CFP. 45-degree field of view. 2352 by 1568 pixels:
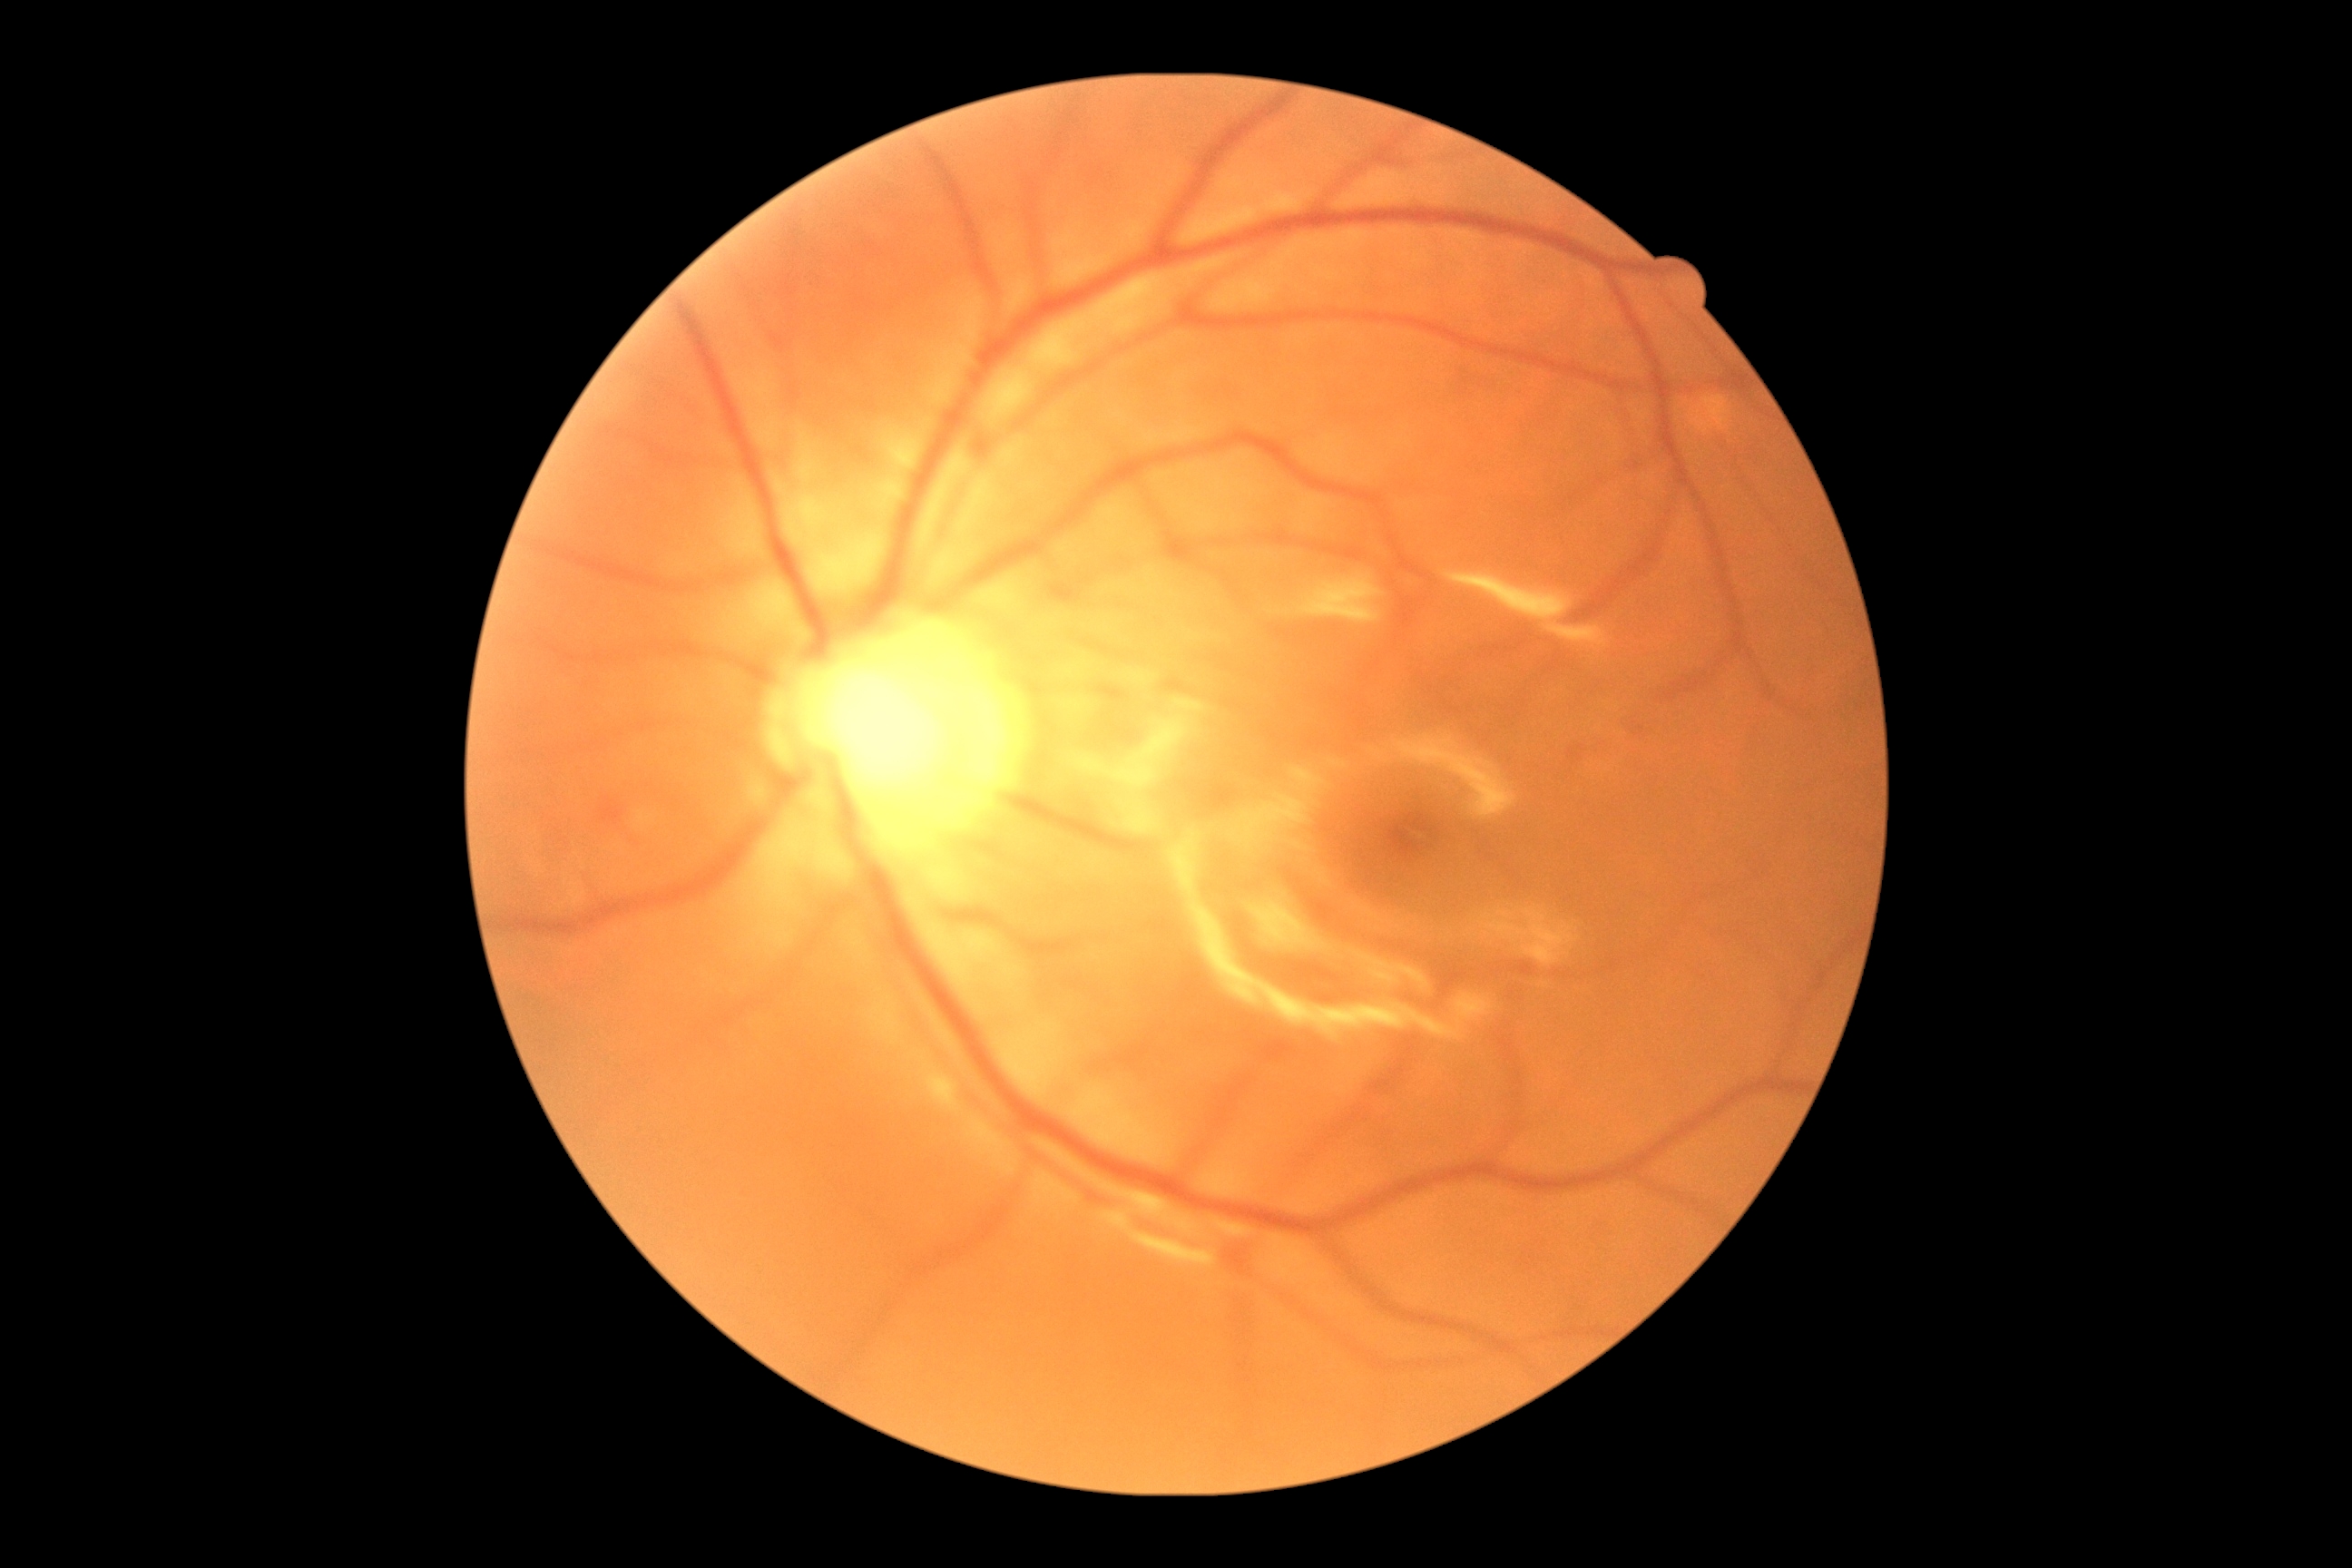 No signs of diabetic retinopathy. DR is grade 0 (no apparent retinopathy).